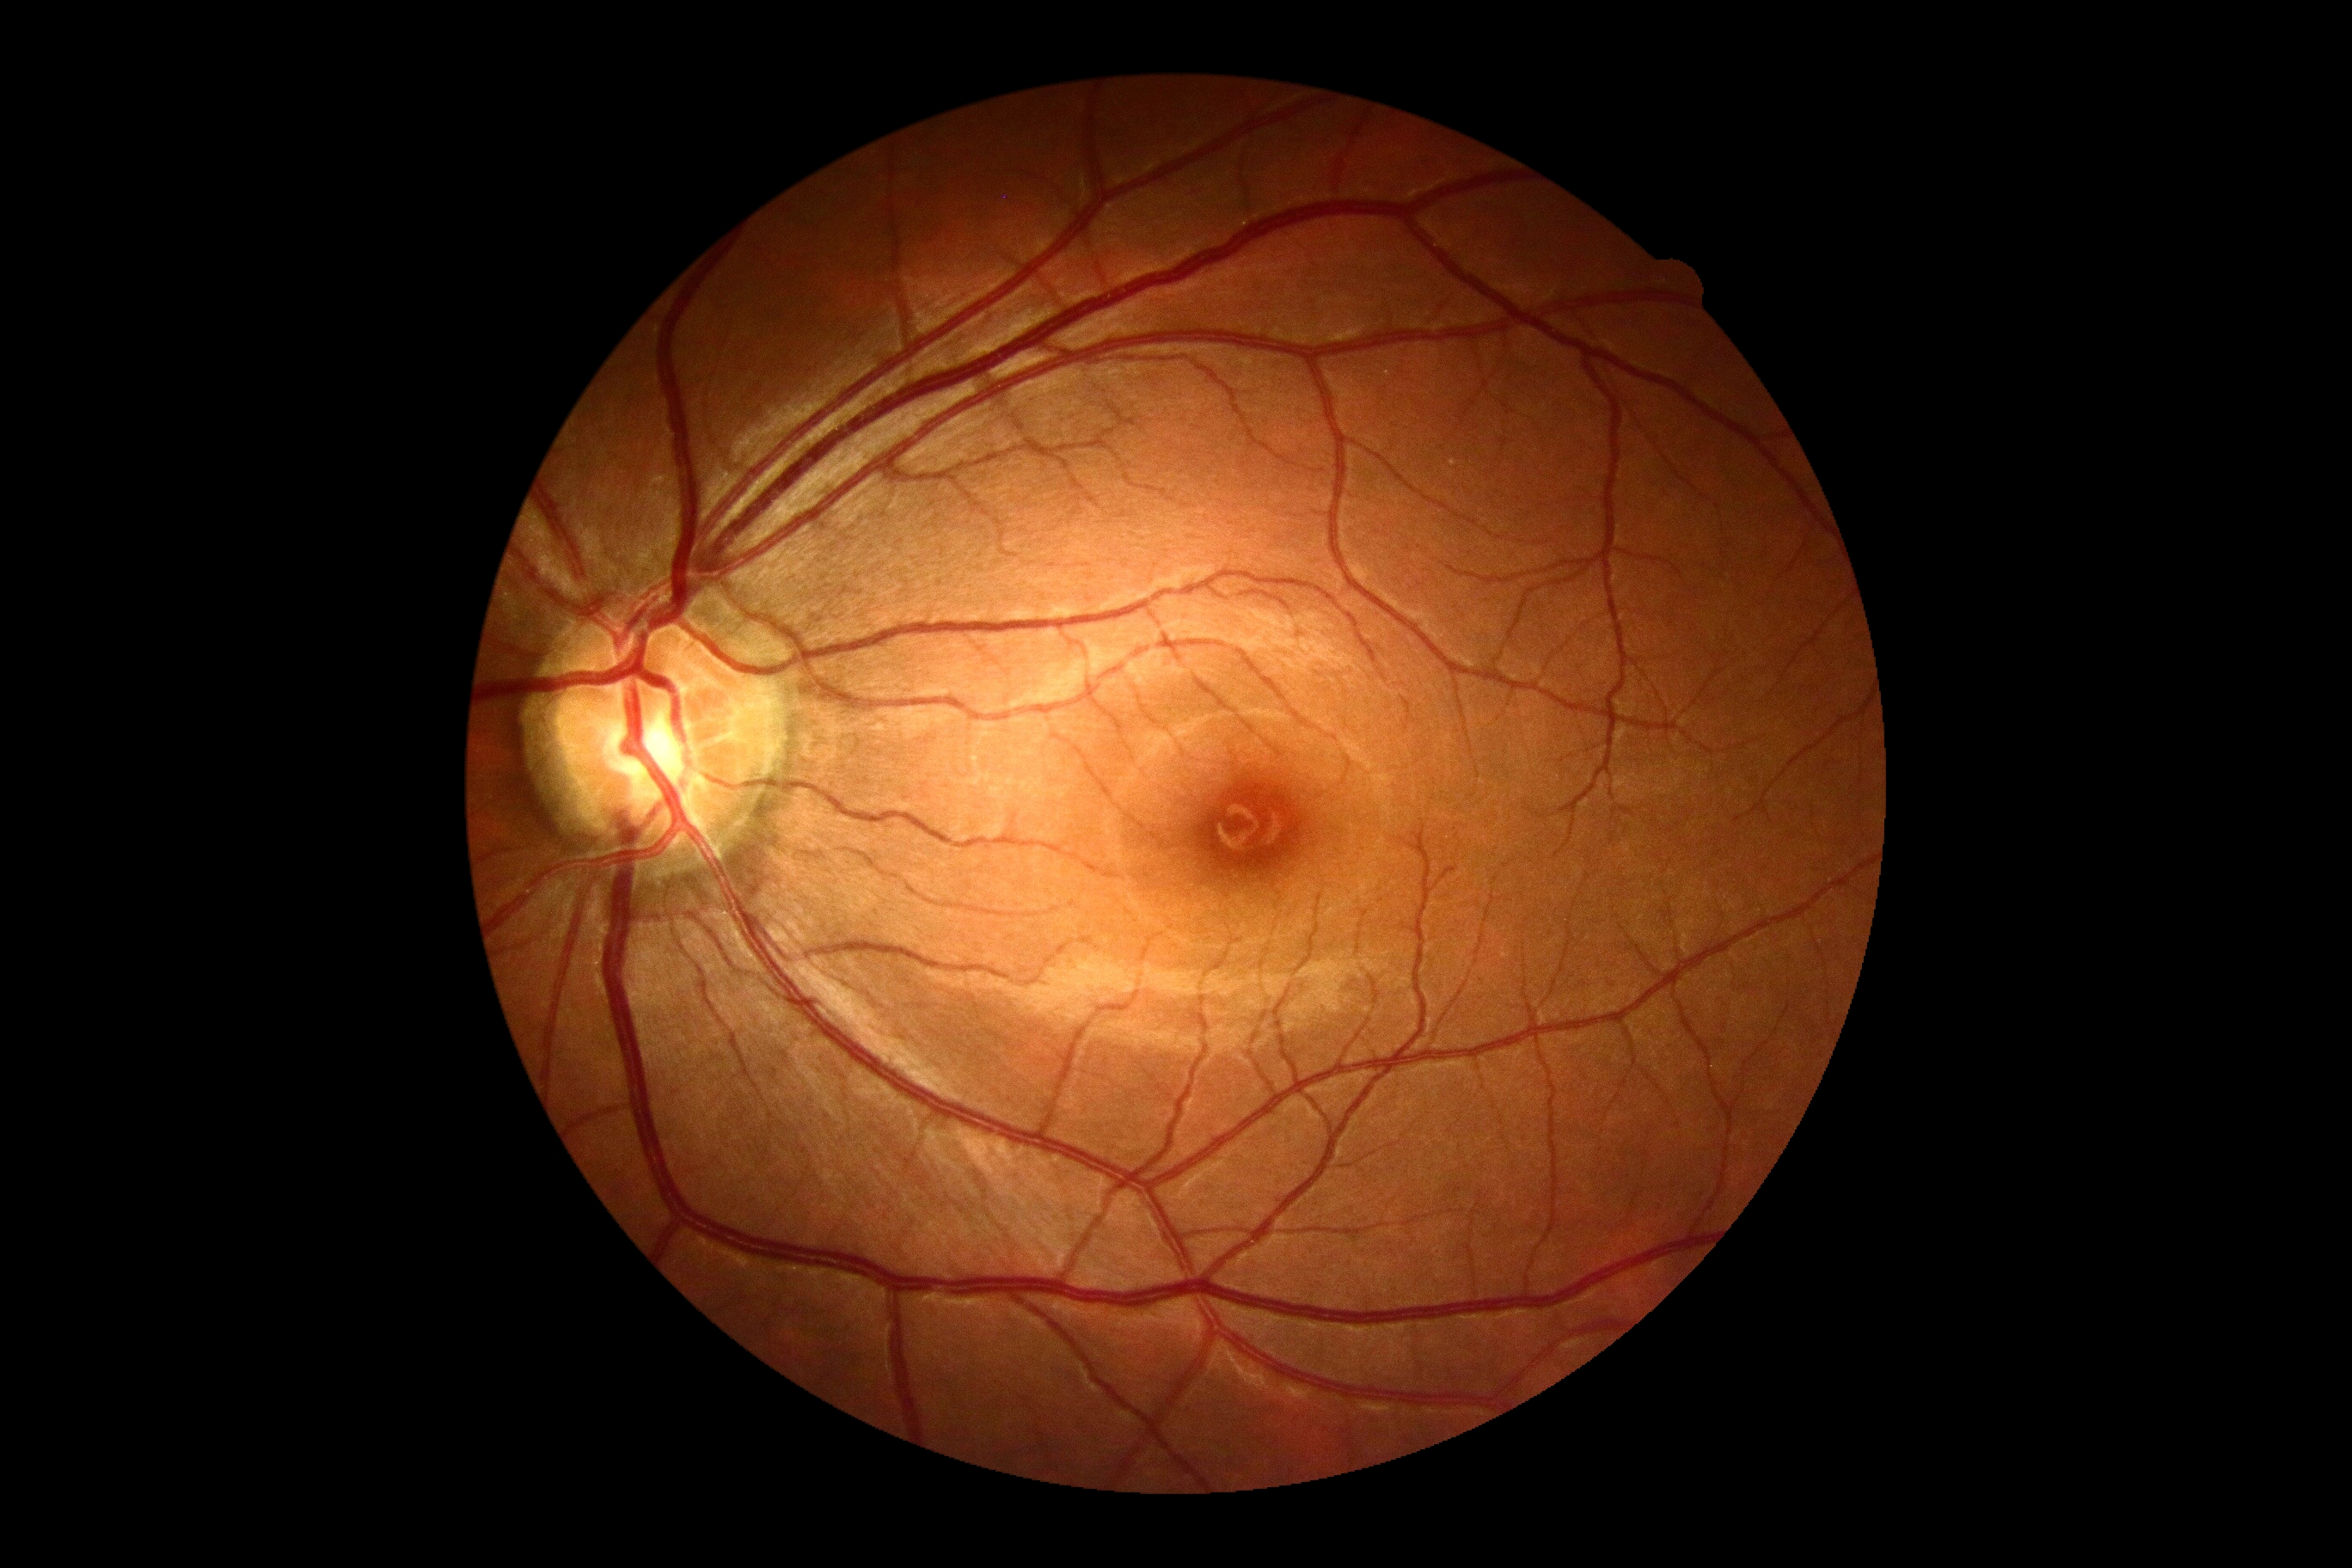

DR impression=negative for DR, diabetic retinopathy=0.